Wide-field contact fundus photograph of an infant; image size 640x480:
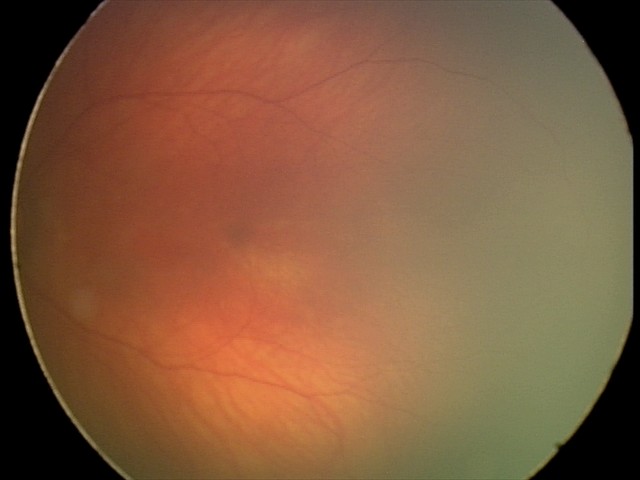
Impression = physiological appearance